Wide-field fundus photograph from neonatal ROP screening · 1440 x 1080 pixels: 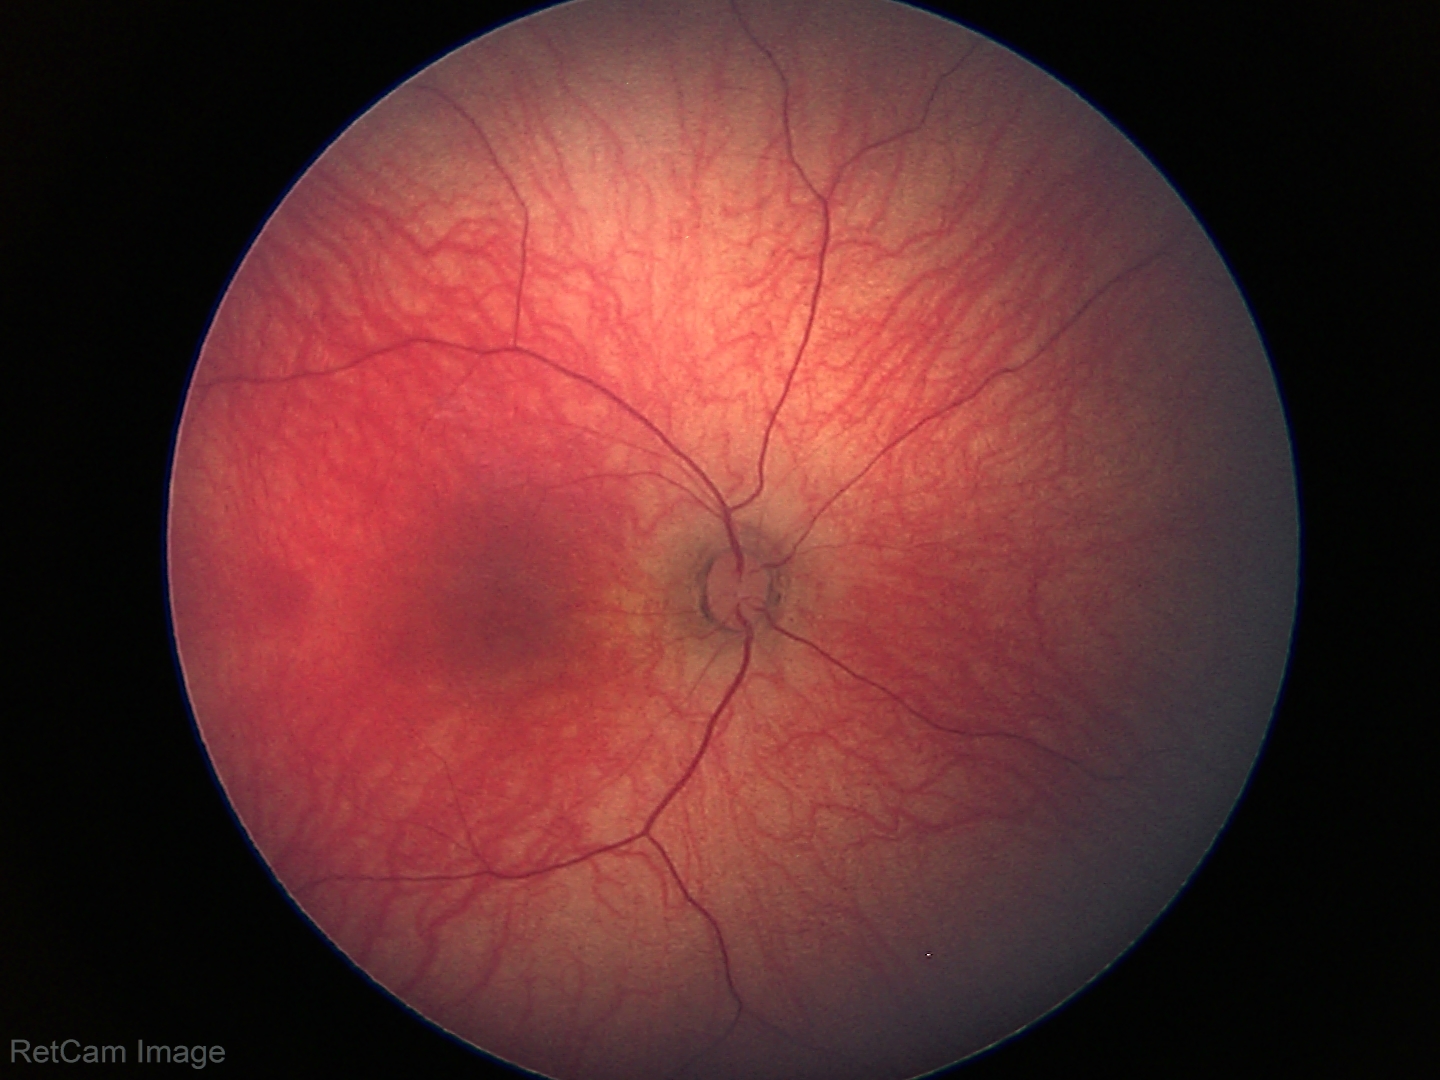 No retinal pathology identified on screening.